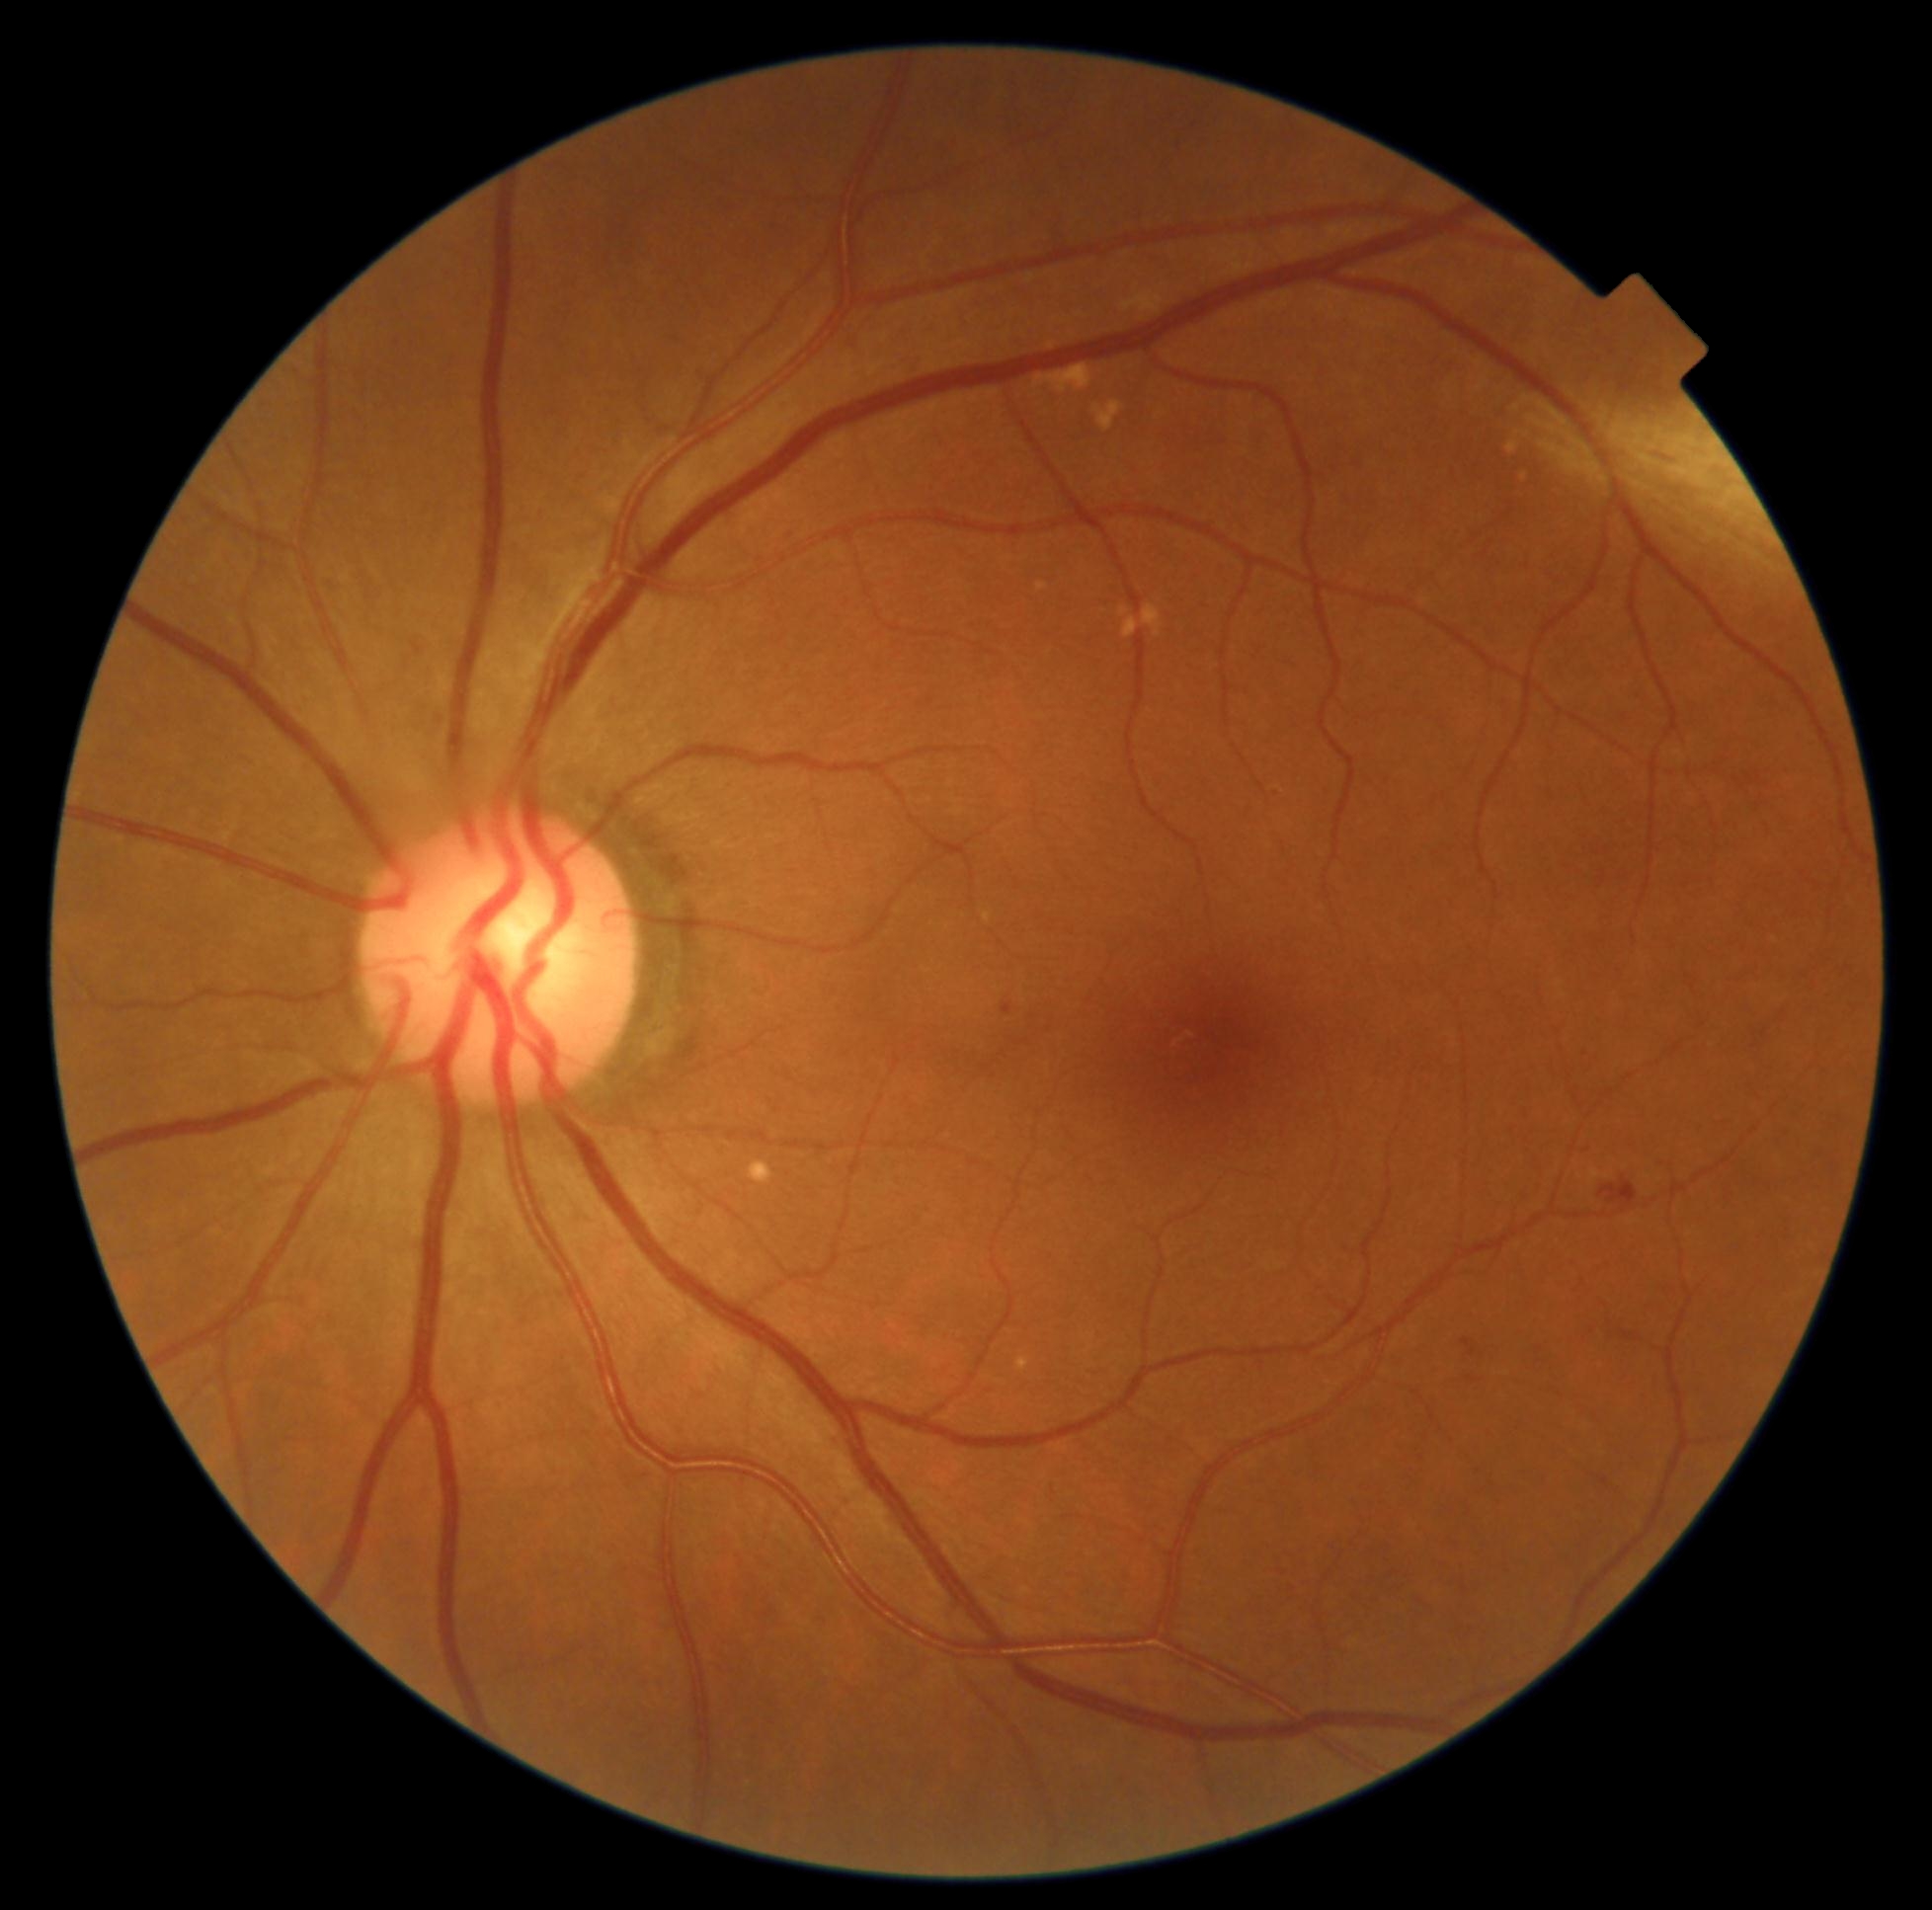

{"partial":true,"dr_grade":2,"dr_grade_name":"moderate NPDR","lesions":{"he":[[1599,1177,1639,1206]],"se":null,"ma":[[1461,1338,1477,1357],[1002,1003,1012,1014]],"ex":null}}